FOV: 45 degrees; modified Davis classification.
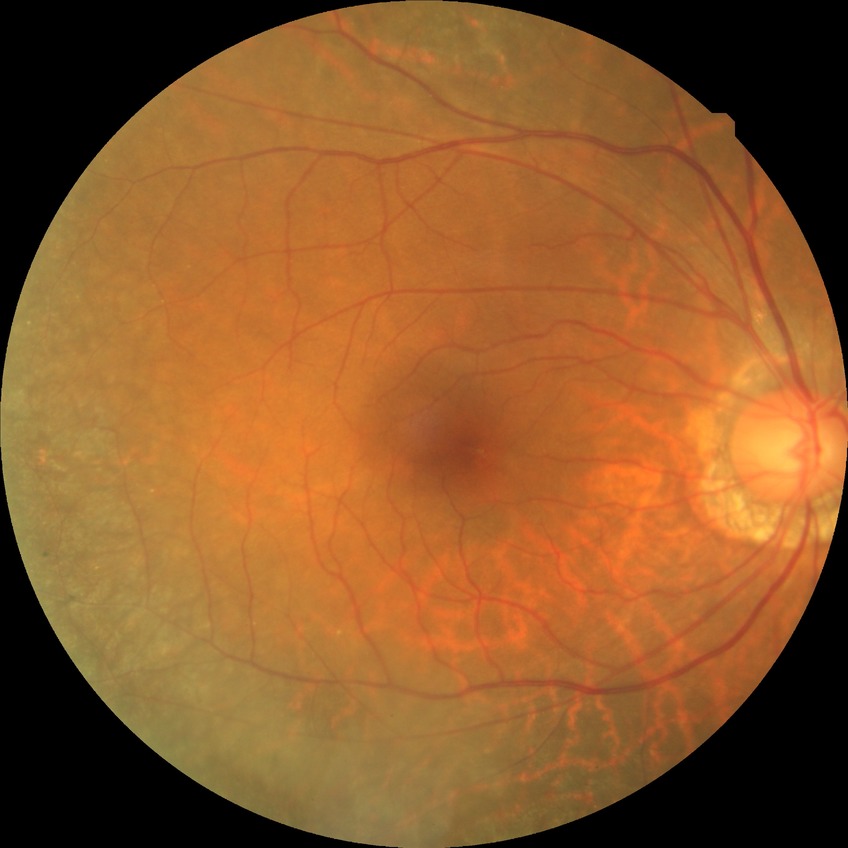 Diabetic retinopathy (DR): NDR (no diabetic retinopathy).